Acquired with a NIDEK AFC-230 · 45-degree field of view · no pharmacologic dilation · modified Davis classification · fundus photo — 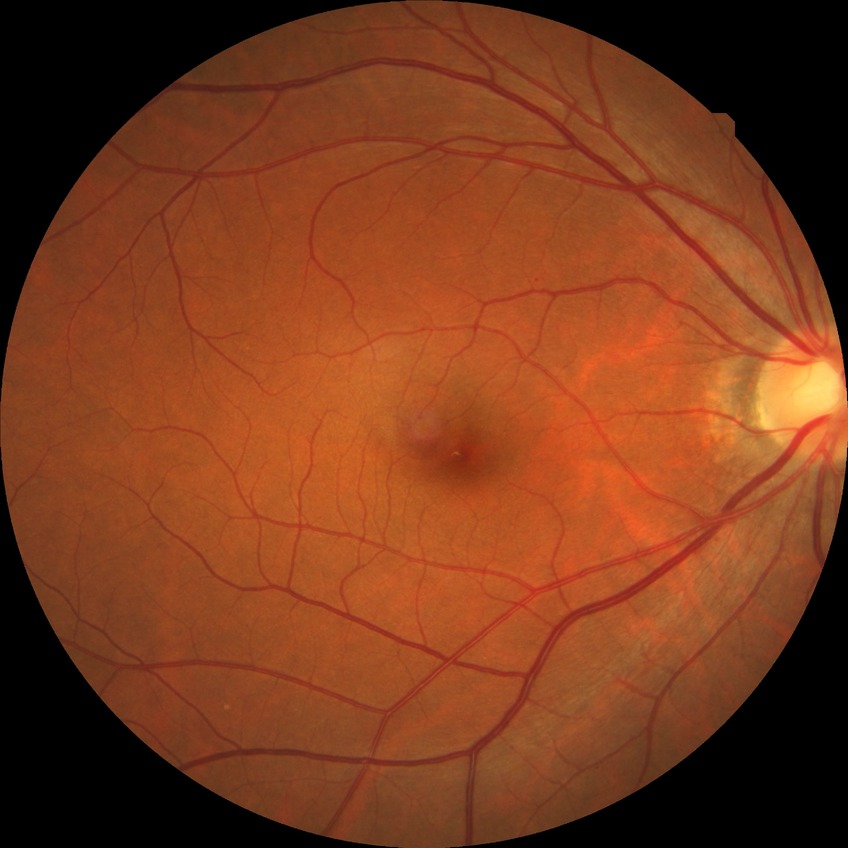
davis_grade: NDR (no diabetic retinopathy)